Image size 640x480; pediatric retinal photograph (wide-field): 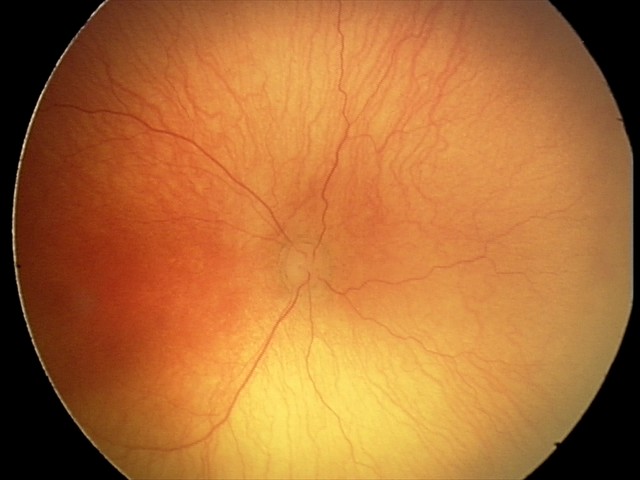

Diagnosis from this screening exam: aggressive retinopathy of prematurity.